45° FOV:
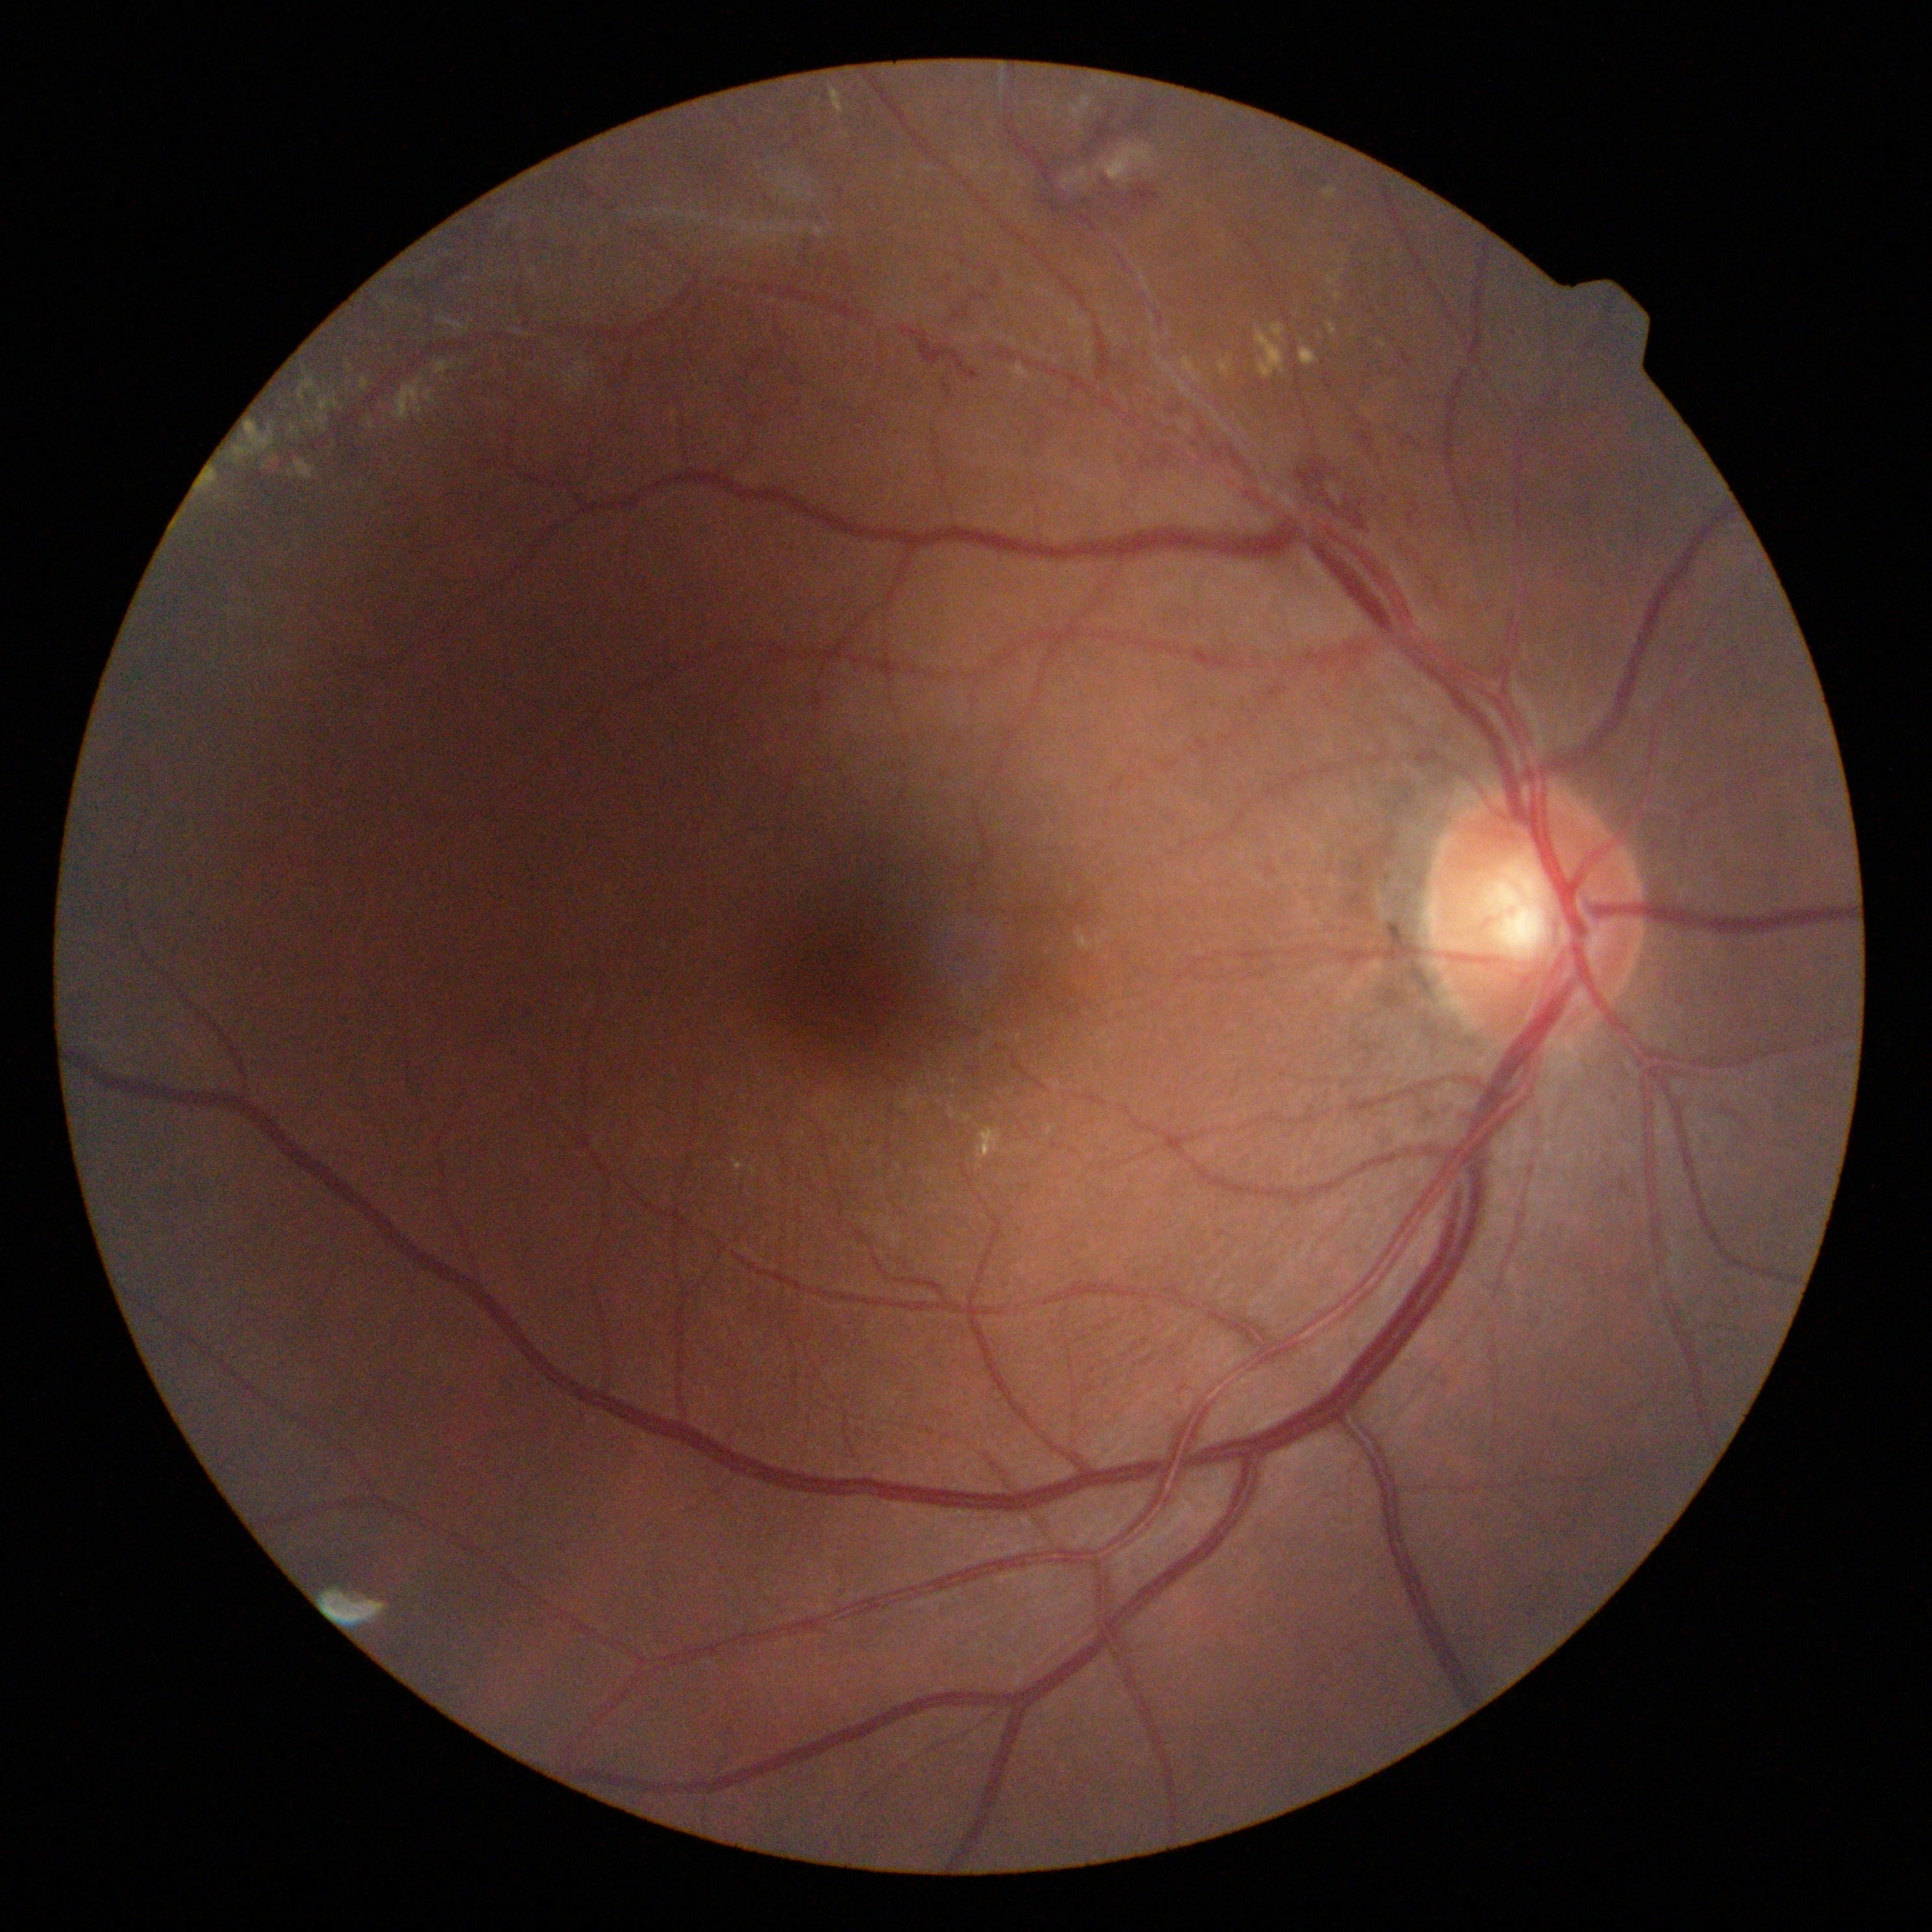
Diabetic retinopathy (DR): severe non-proliferative diabetic retinopathy (grade 3) — more than 20 intraretinal hemorrhages in each of 4 quadrants, definite venous beading in 2 or more quadrants, or prominent intraretinal microvascular abnormalities in 1 or more quadrants, with no signs of proliferative retinopathy.